45° field of view, image size 1932x1916: 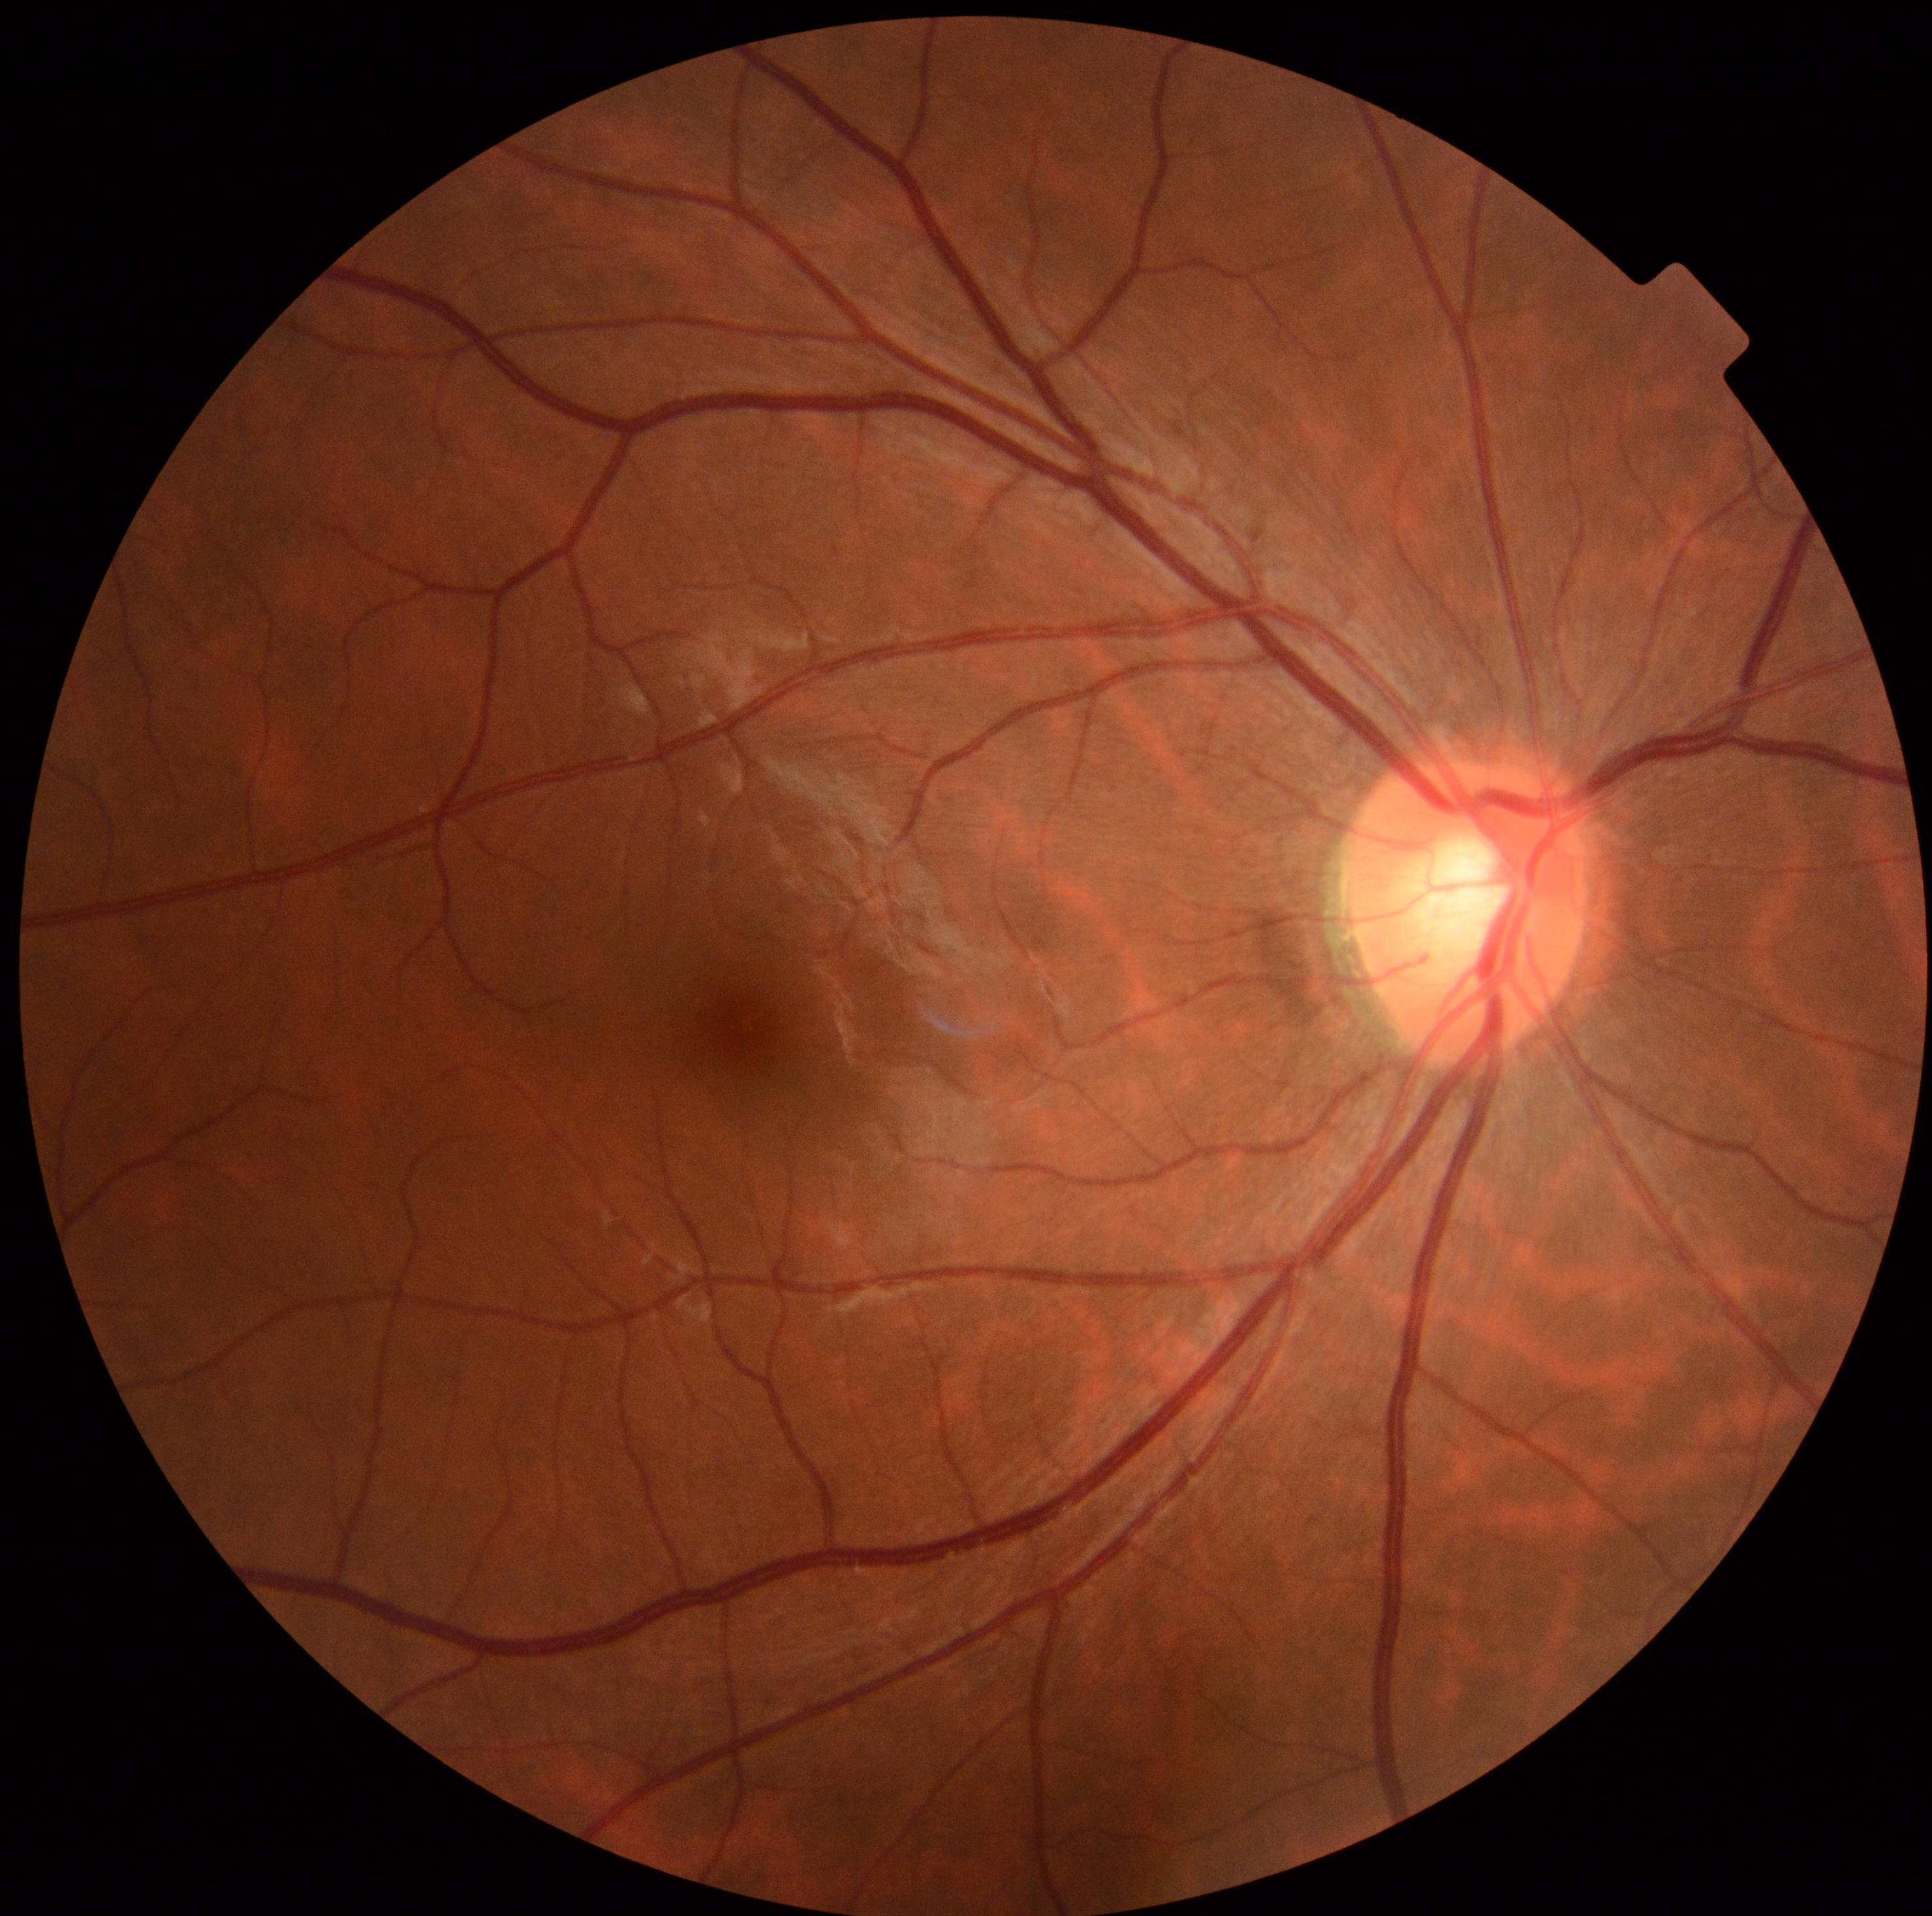 DR stage is 0.
No diabetic retinal disease findings.